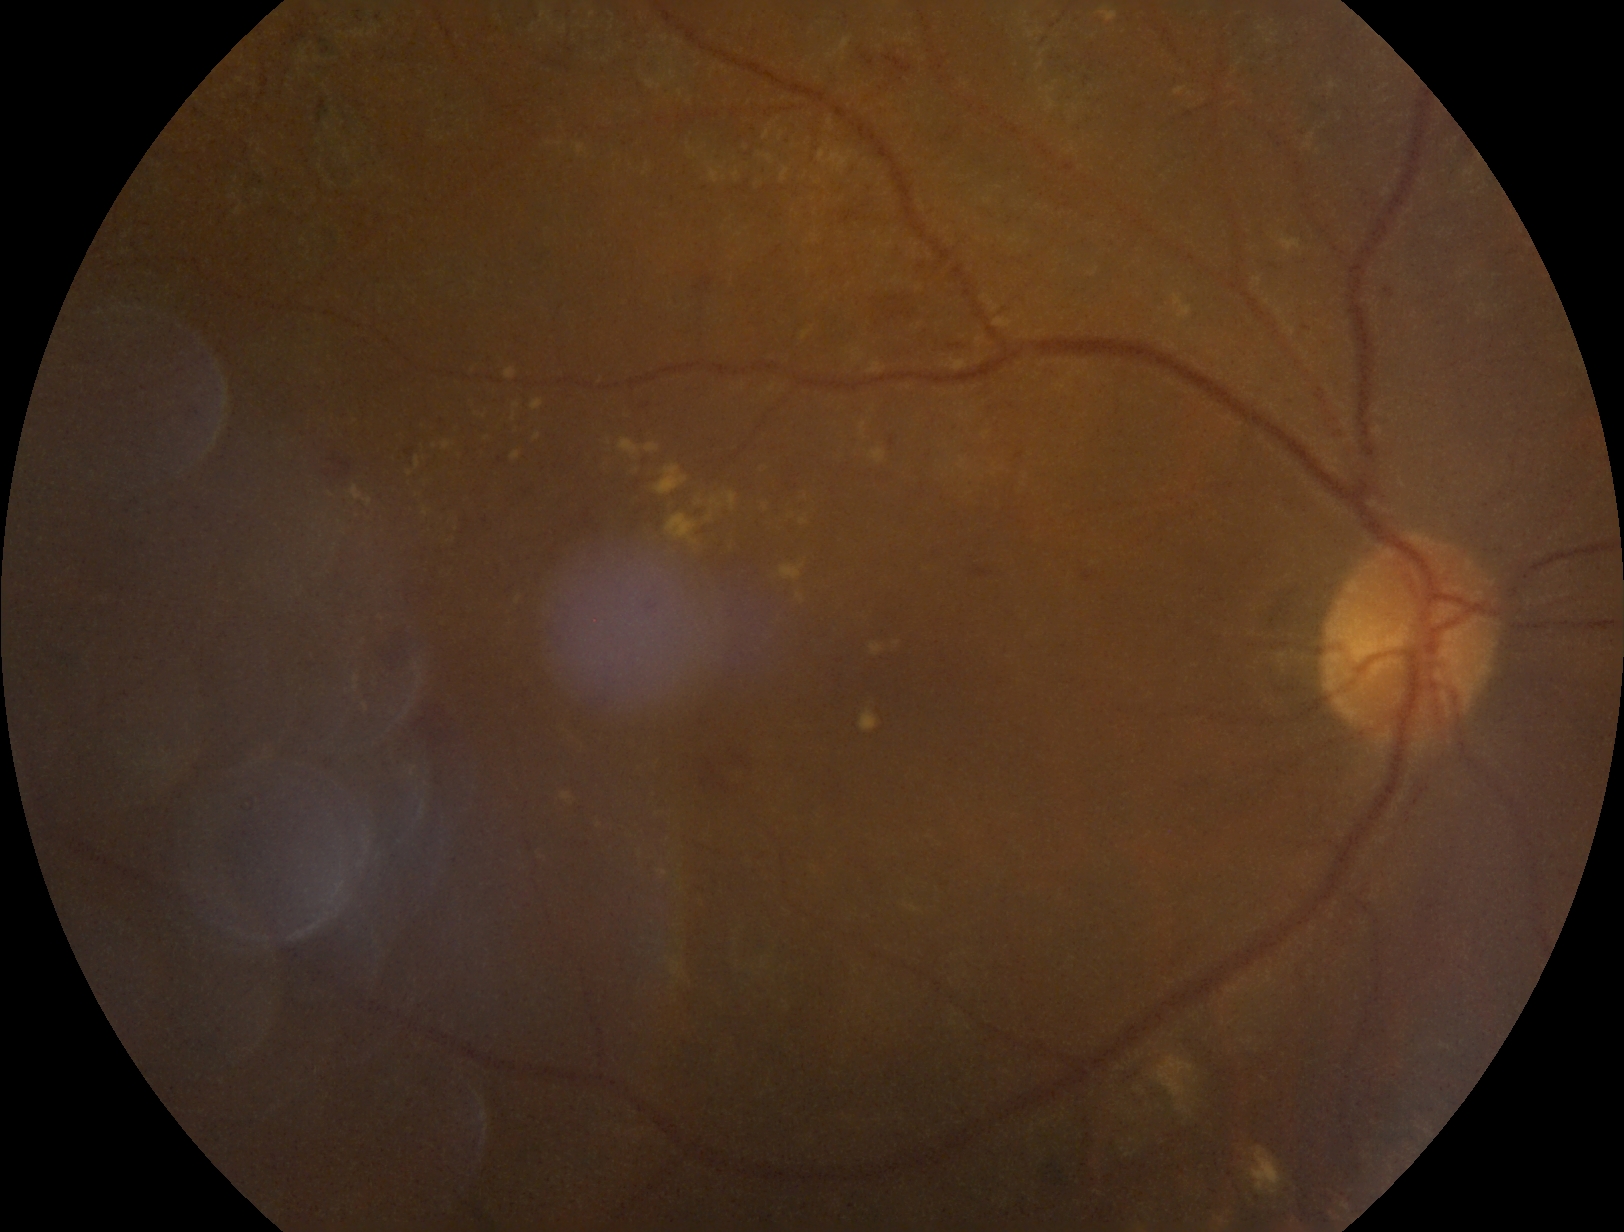
DR class: non-proliferative diabetic retinopathy
DR stage: 2 — more than just microaneurysms but less than severe NPDR